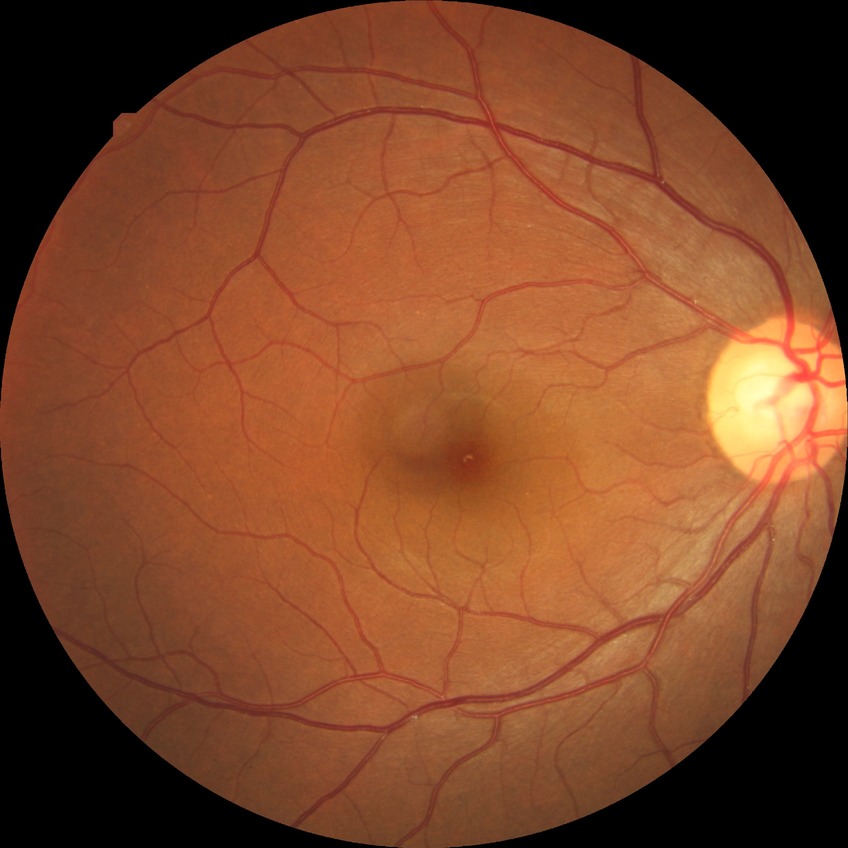
Retinopathy stage is no diabetic retinopathy.